Color fundus image — 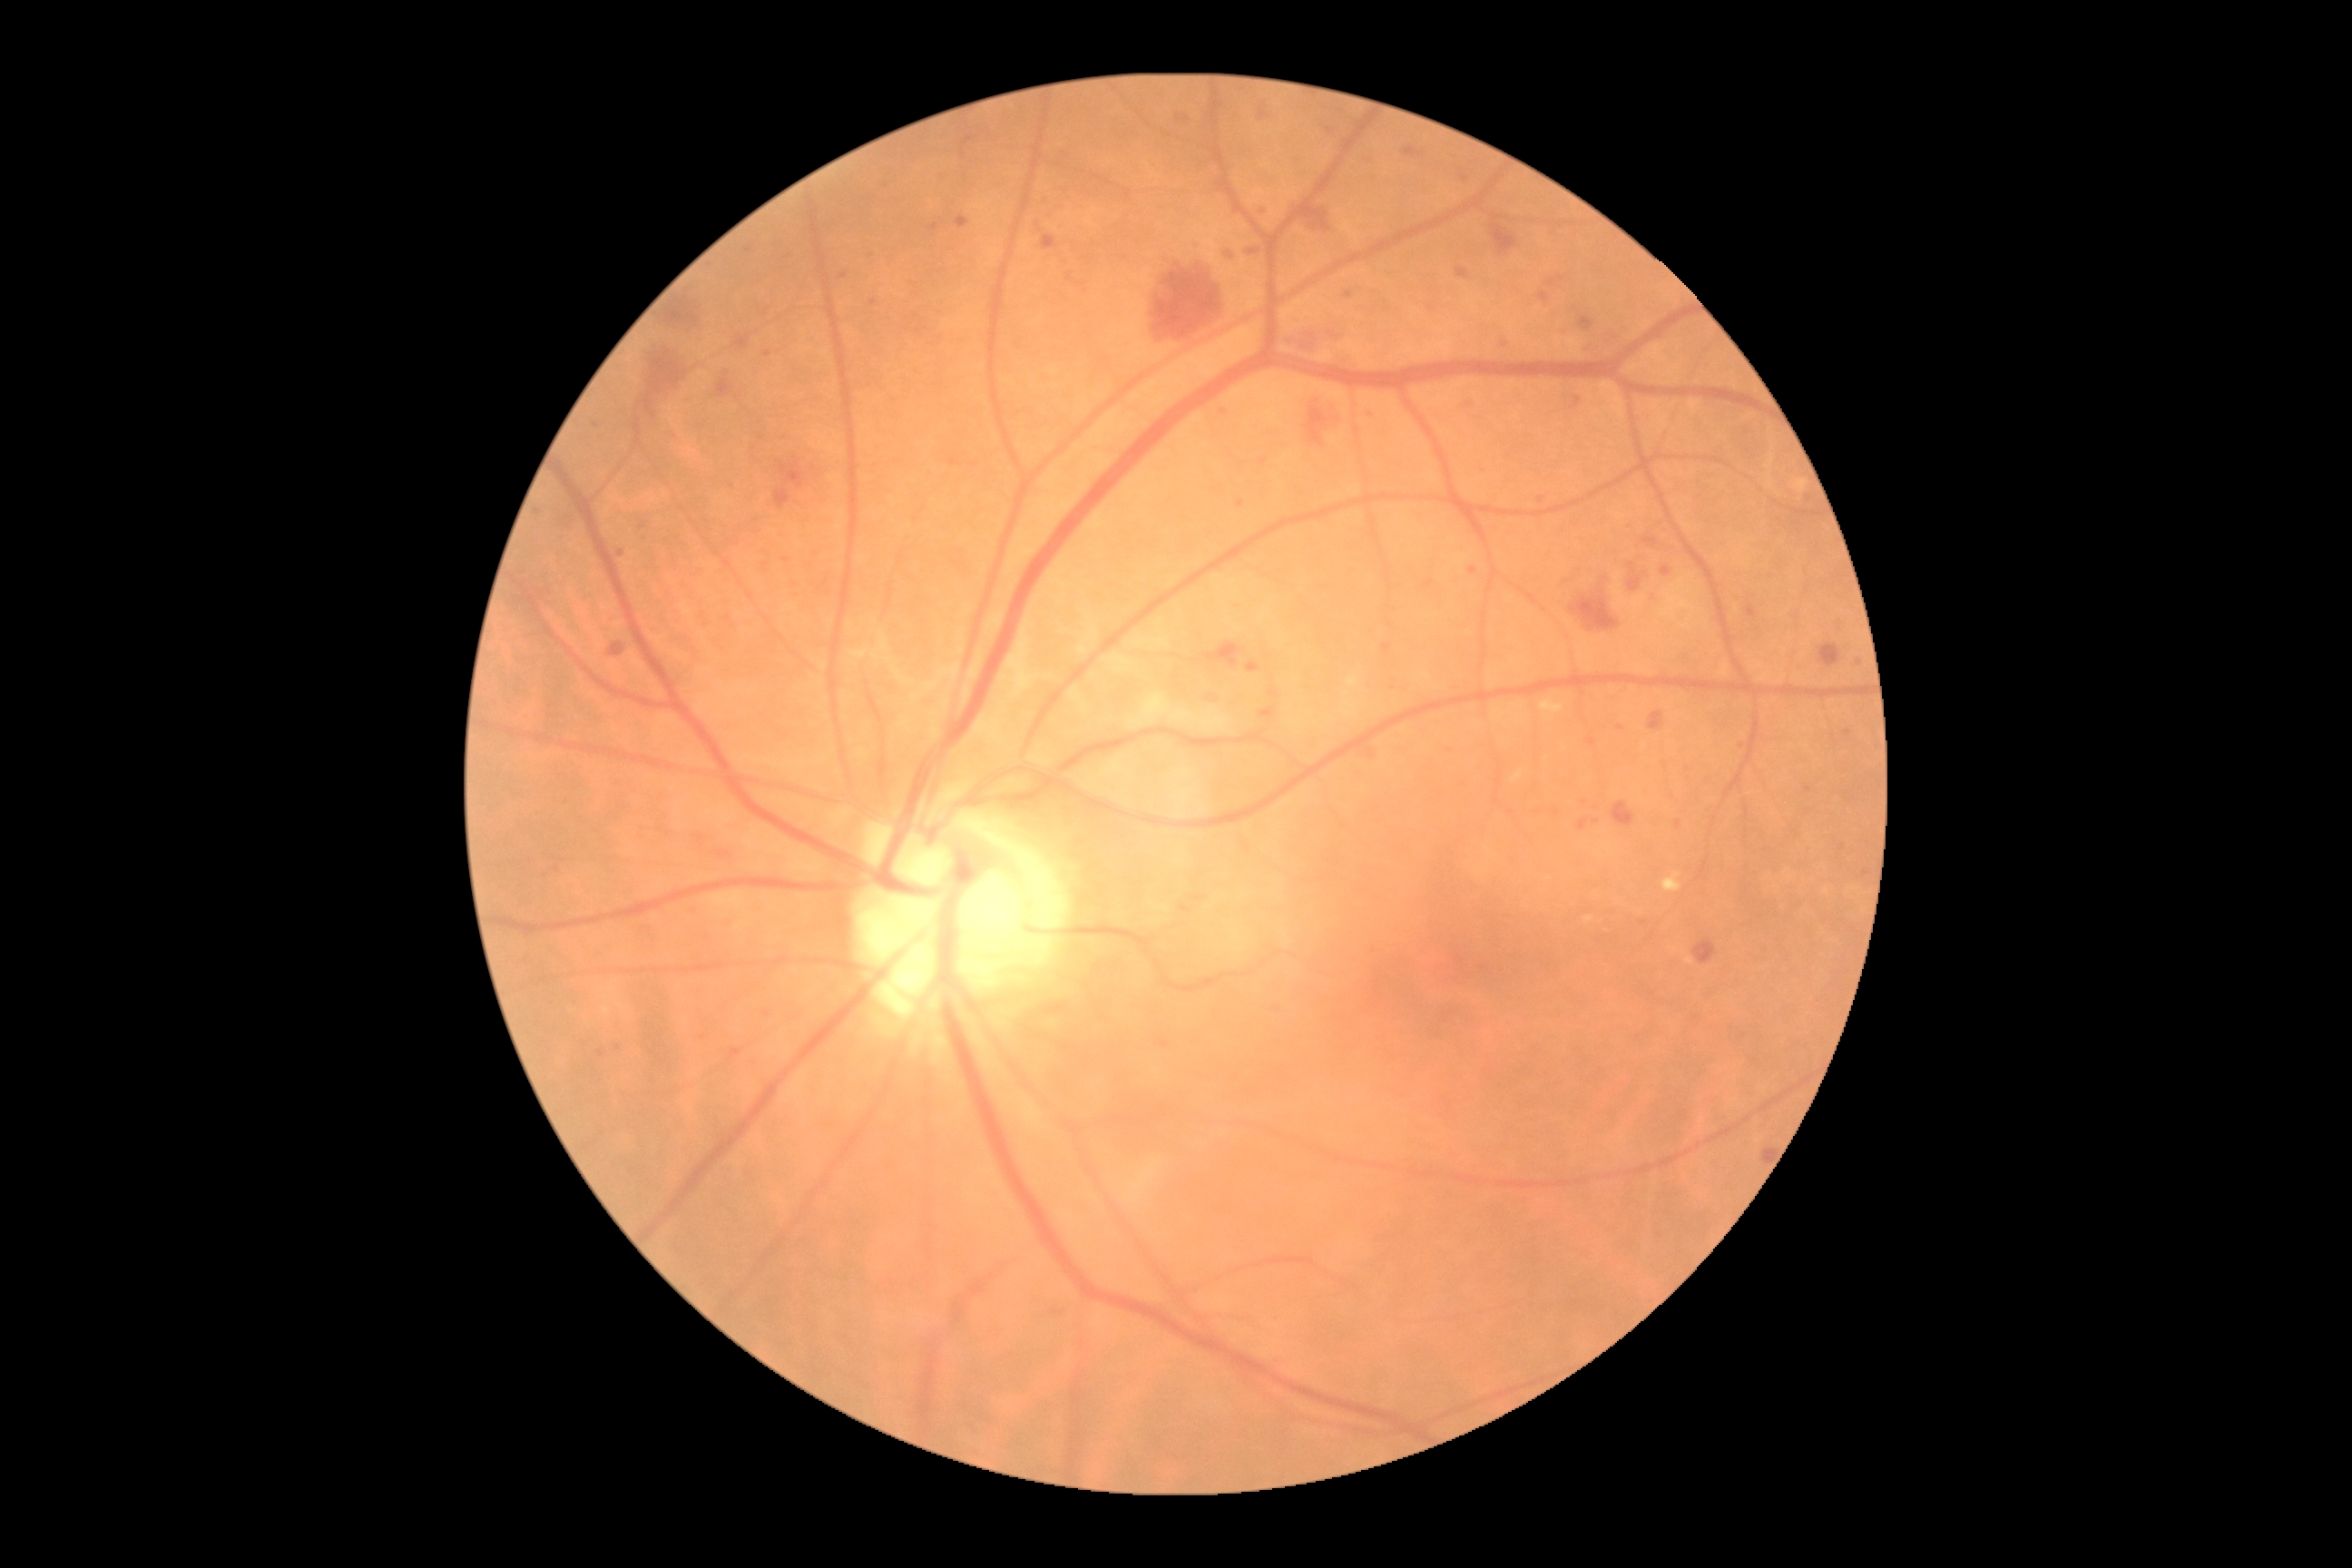 Diabetic retinopathy grade is 2.